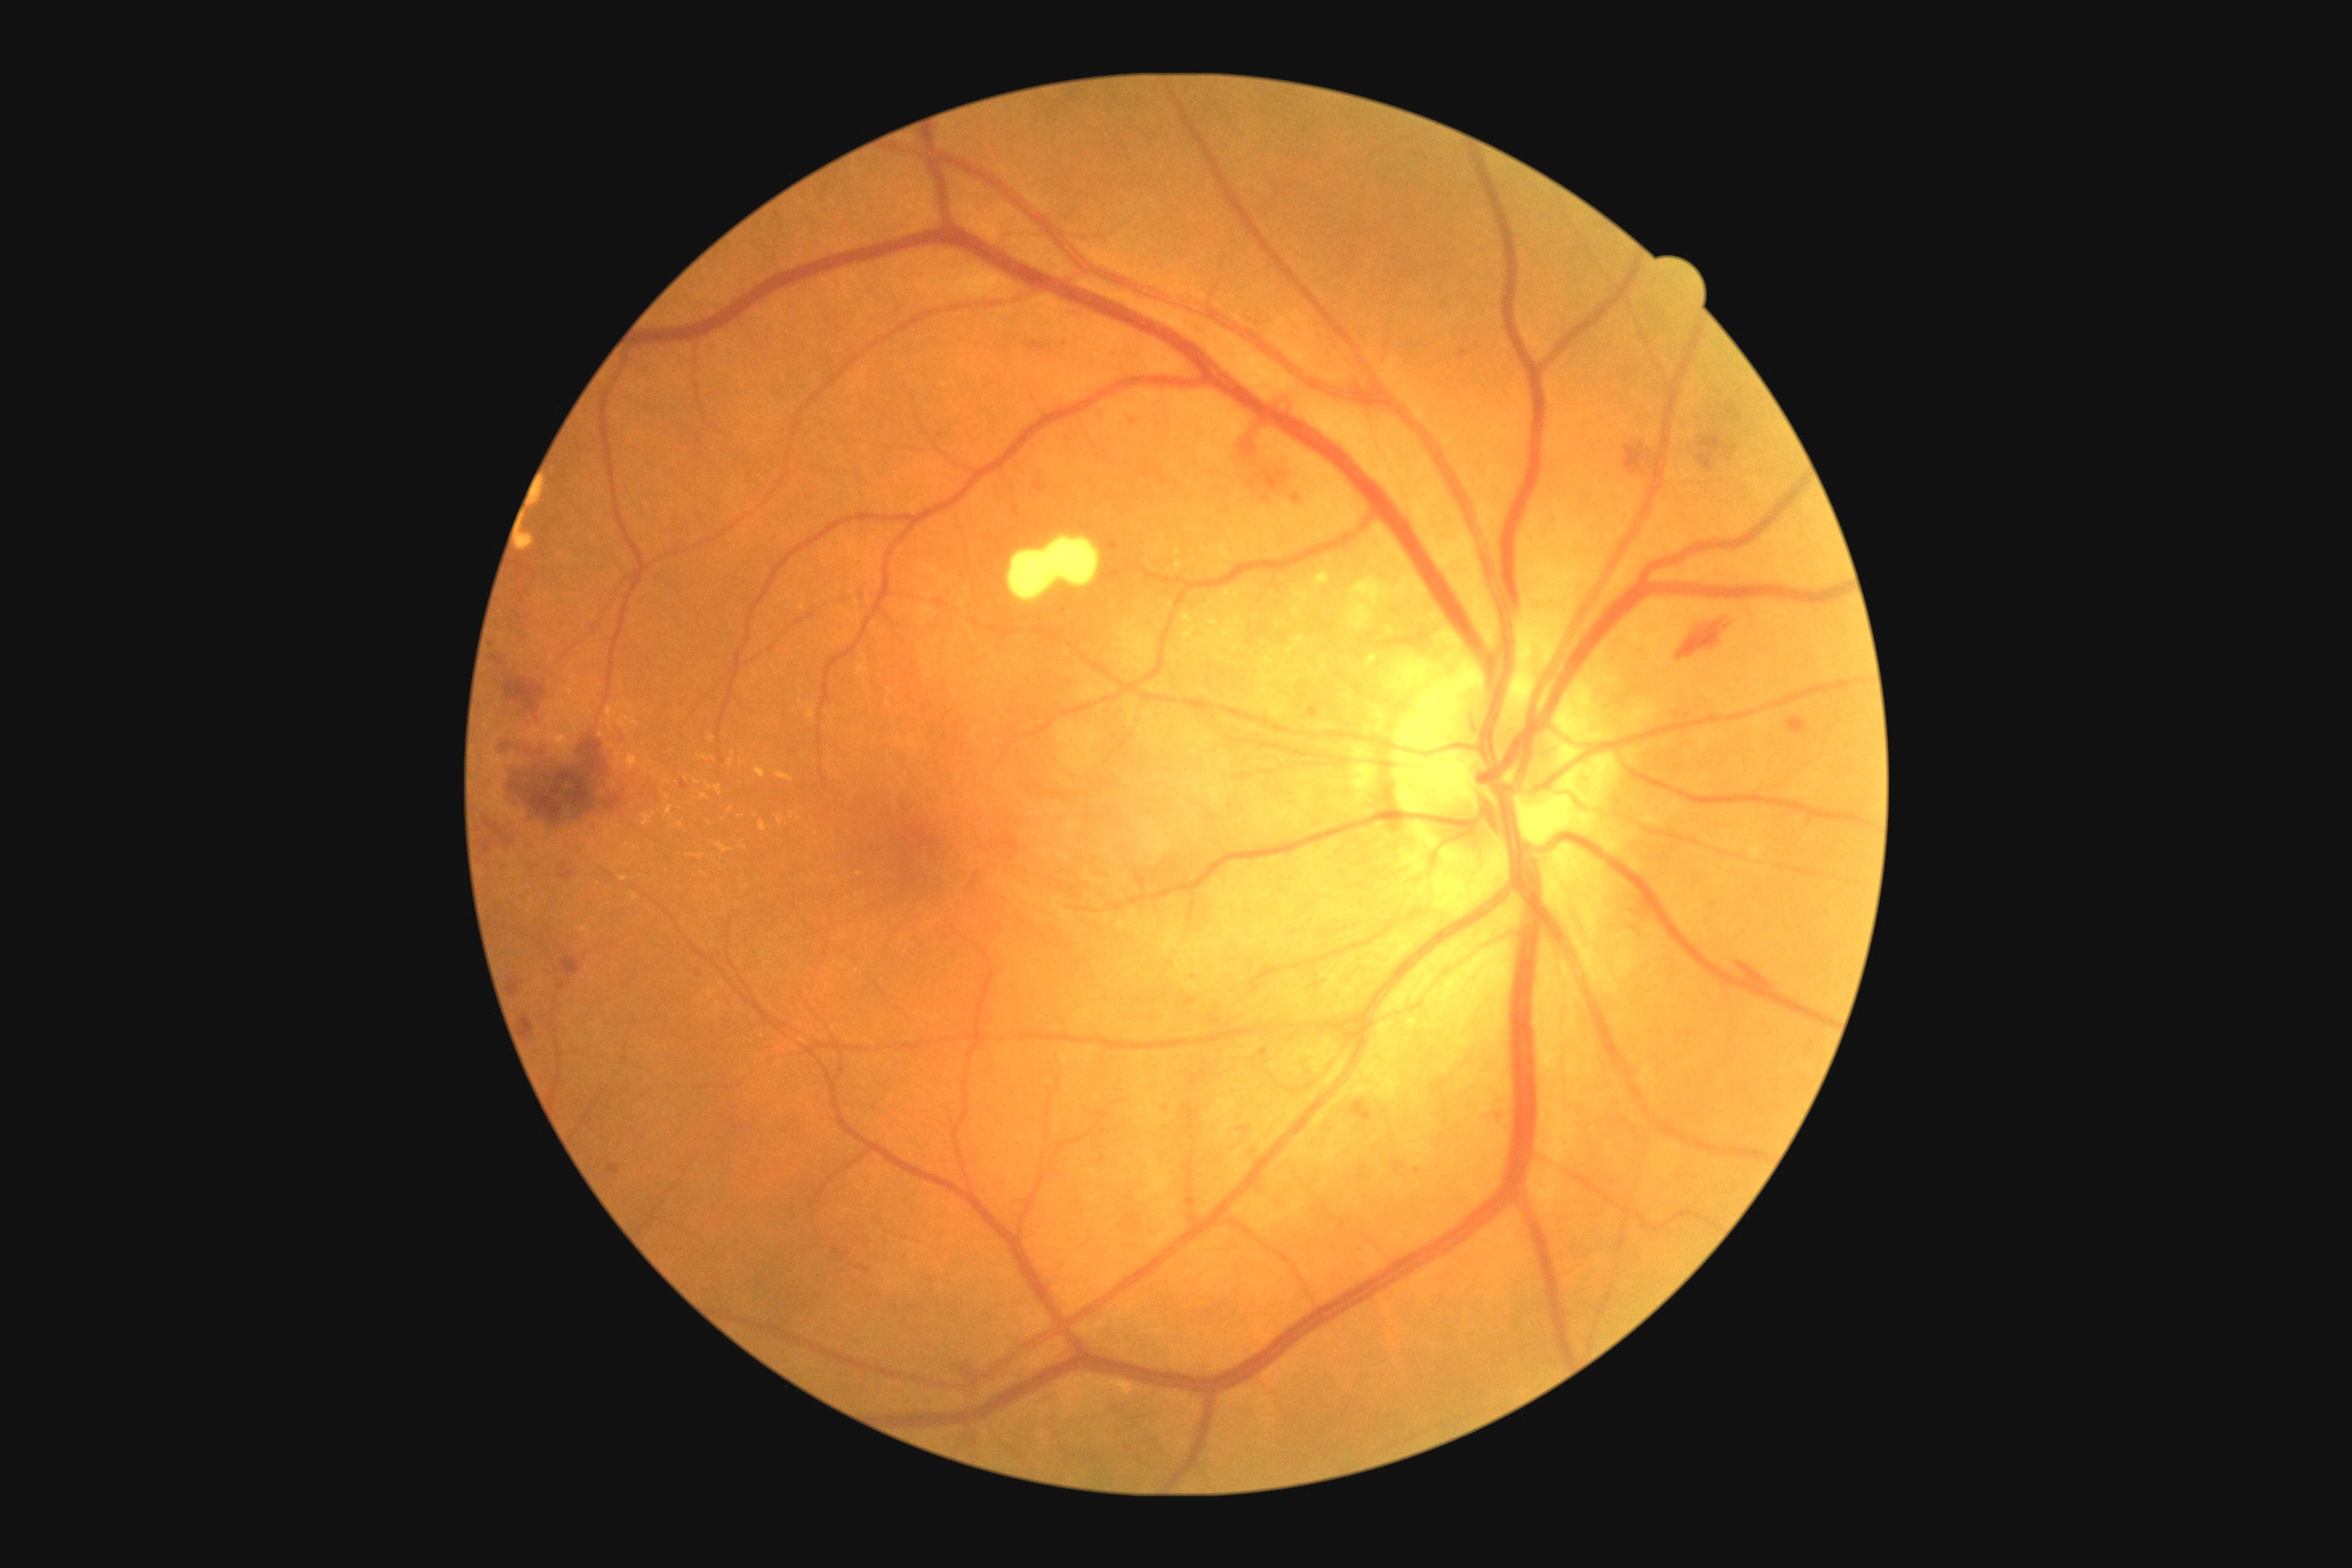 Diabetic retinopathy (DR) is grade 2 (moderate NPDR)
A subset of detected lesions:
hemorrhages (HEs) (subset): <region>1106, 544, 1119, 553</region>; <region>516, 614, 524, 622</region>; <region>1807, 1041, 1816, 1052</region>; <region>950, 1358, 983, 1382</region>; <region>562, 957, 580, 977</region>; <region>858, 1266, 872, 1273</region>; <region>480, 799, 540, 879</region>; <region>1034, 471, 1046, 495</region>; <region>522, 1017, 534, 1037</region>; <region>1698, 431, 1736, 473</region>; <region>1625, 435, 1651, 480</region>
Additional small HEs near point(527, 593); point(1164, 483); point(844, 1256); point(1418, 1170)
hard exudates (EXs) (subset): <region>1317, 569, 1329, 585</region>; <region>1367, 654, 1380, 667</region>; <region>1175, 560, 1182, 573</region>; <region>667, 807, 672, 818</region>; <region>620, 877, 629, 883</region>; <region>1289, 638, 1308, 656</region>; <region>760, 821, 767, 832</region>; <region>623, 756, 640, 770</region>; <region>698, 754, 714, 761</region>
Additional small EXs near point(731, 809); point(698, 783); point(601, 735); point(635, 897)